848 x 848 pixels, NIDEK AFC-230, fundus photo, 45° FOV: 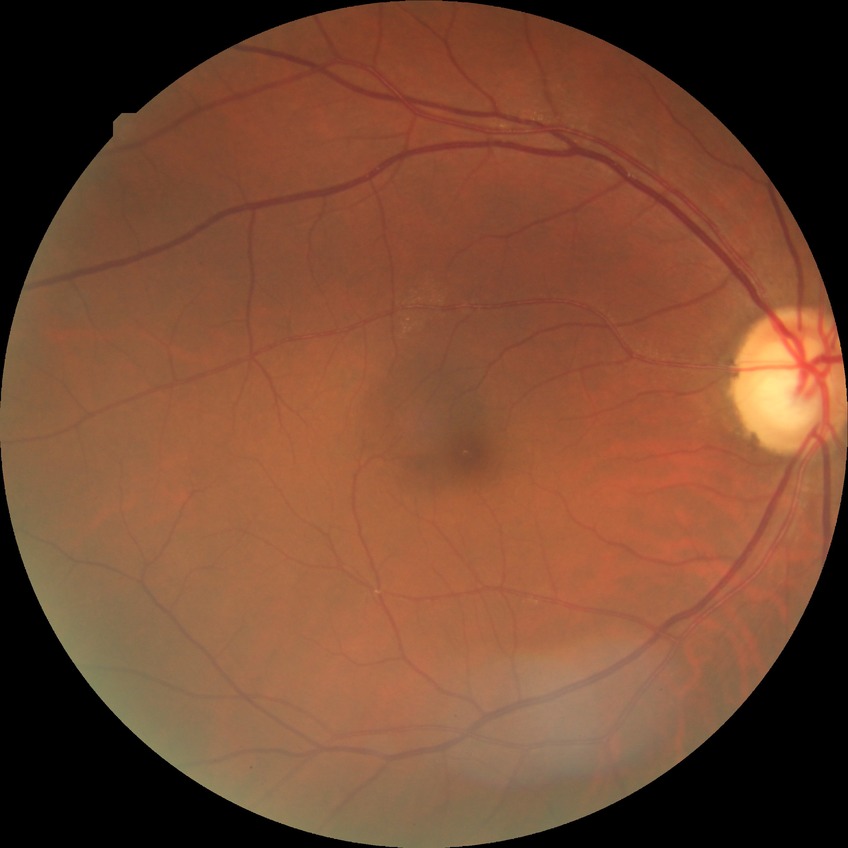

Diabetic retinopathy (DR): no diabetic retinopathy (NDR).